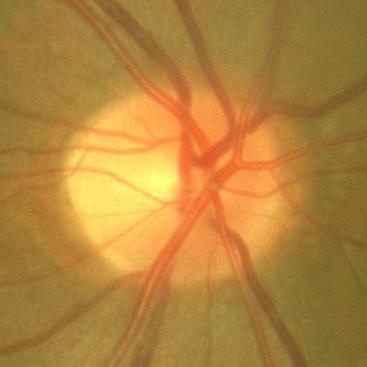

Q: Is there glaucomatous optic neuropathy?
A: No — no glaucoma.